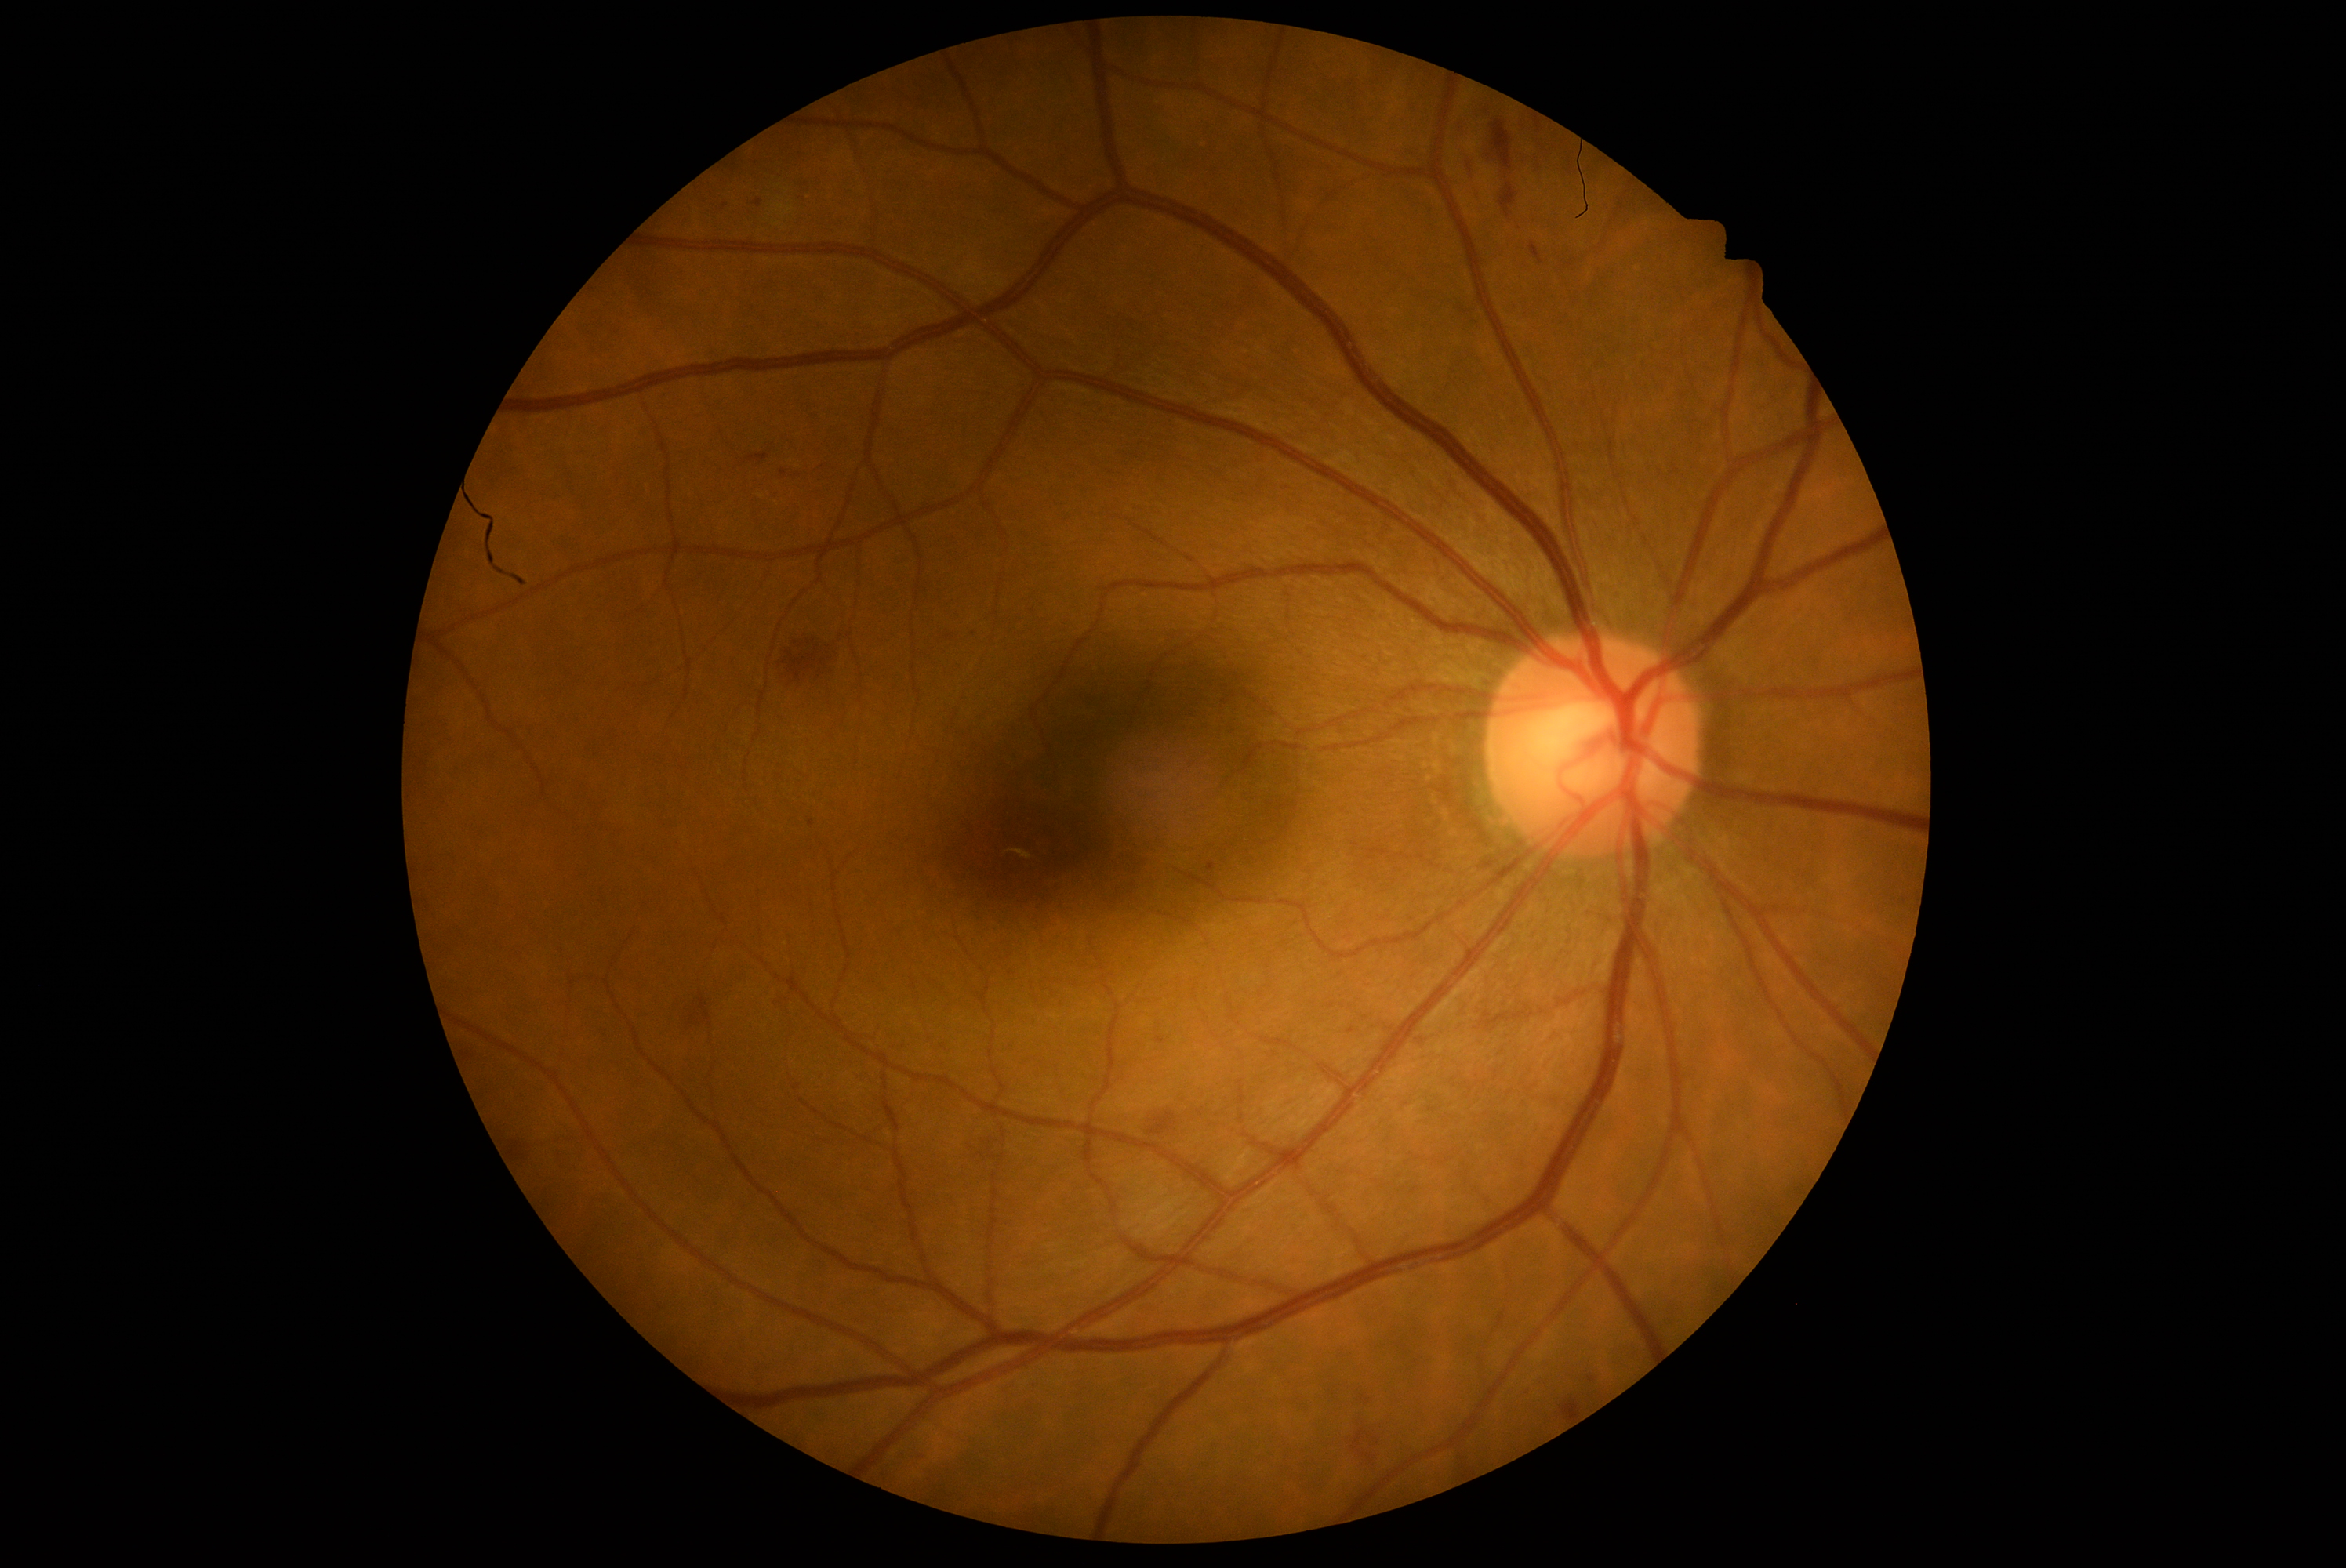

Diabetic retinopathy severity: grade 2 (moderate NPDR).